Color fundus photograph
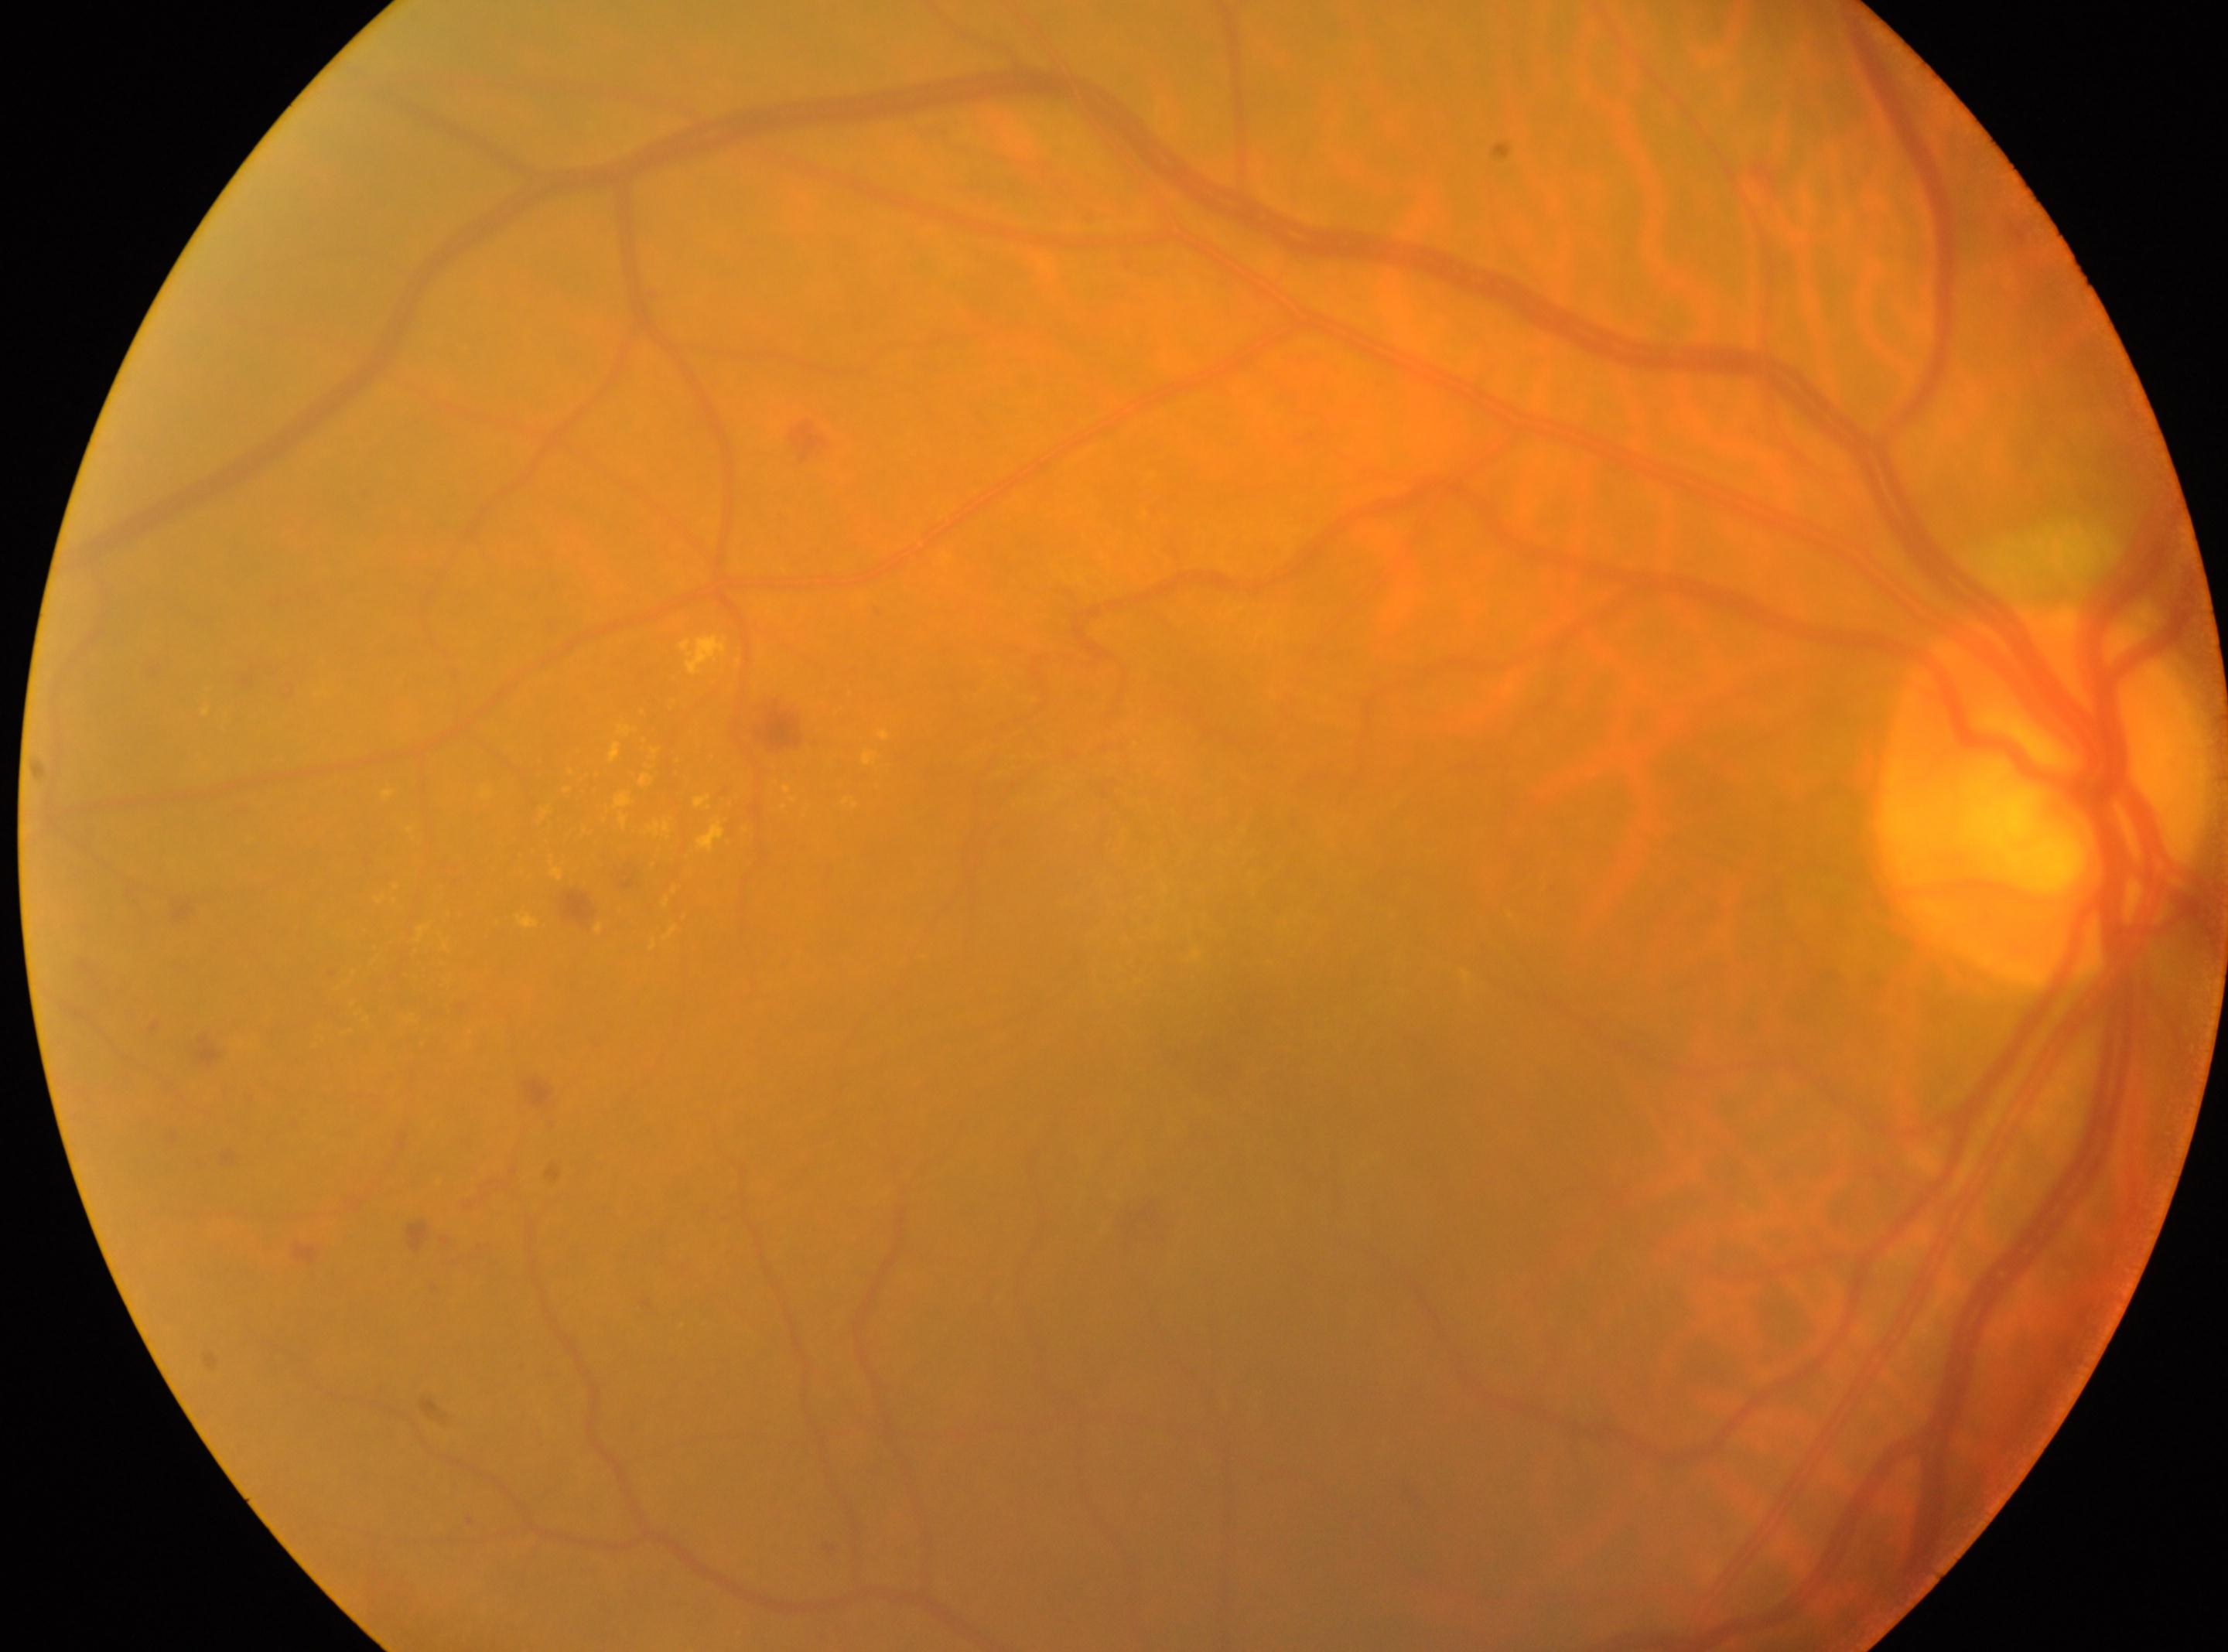

- optic nerve head — (2041, 792)
- laterality — right
- DR — 2/4 — more than just microaneurysms but less than severe NPDR
- fovea — (1205, 1046)